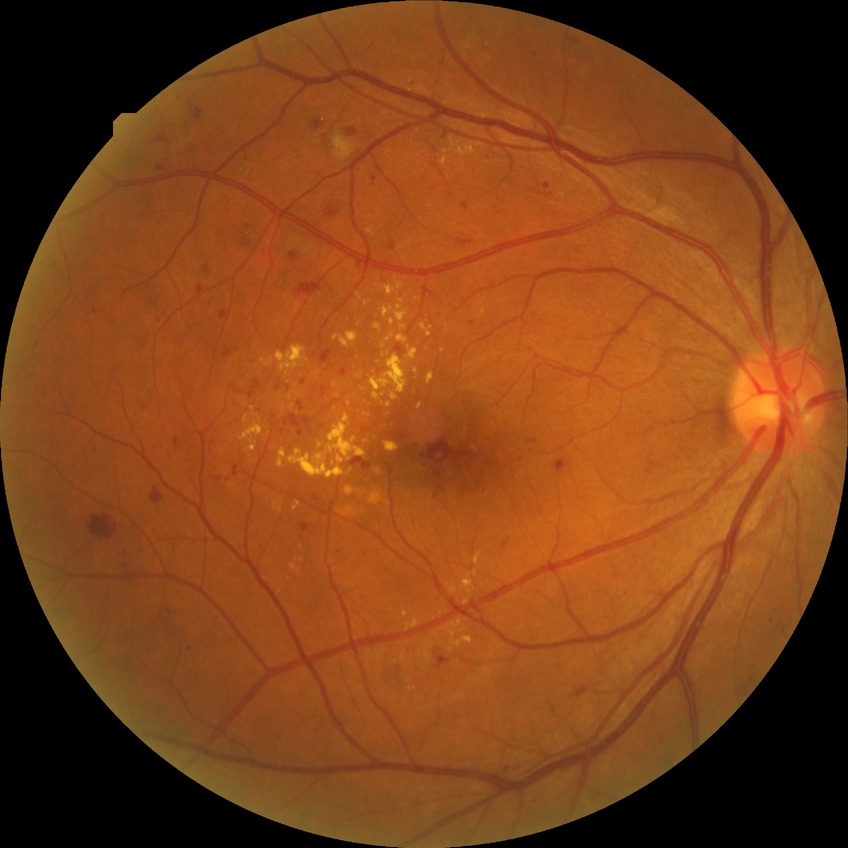

Findings:
* DR class: non-proliferative diabetic retinopathy
* Davis grade: PPDR